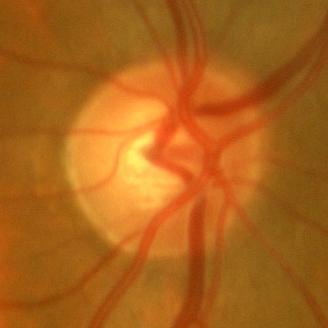 Optic nerve head photograph demonstrating no glaucoma.